Modified Davis classification — 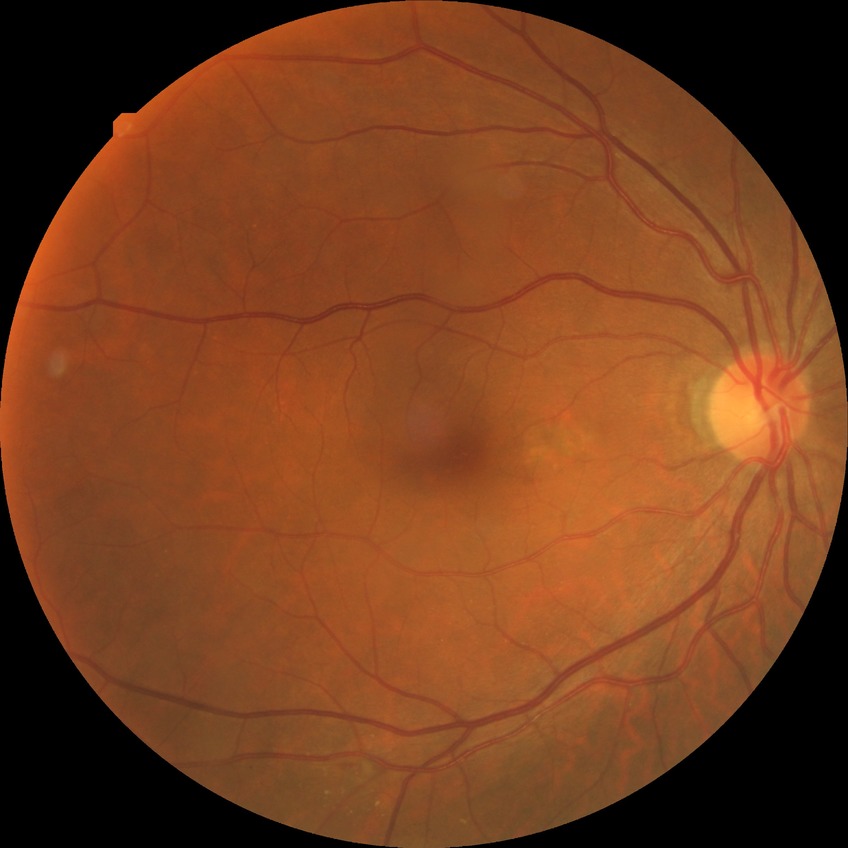 Modified Davis classification is simple diabetic retinopathy.